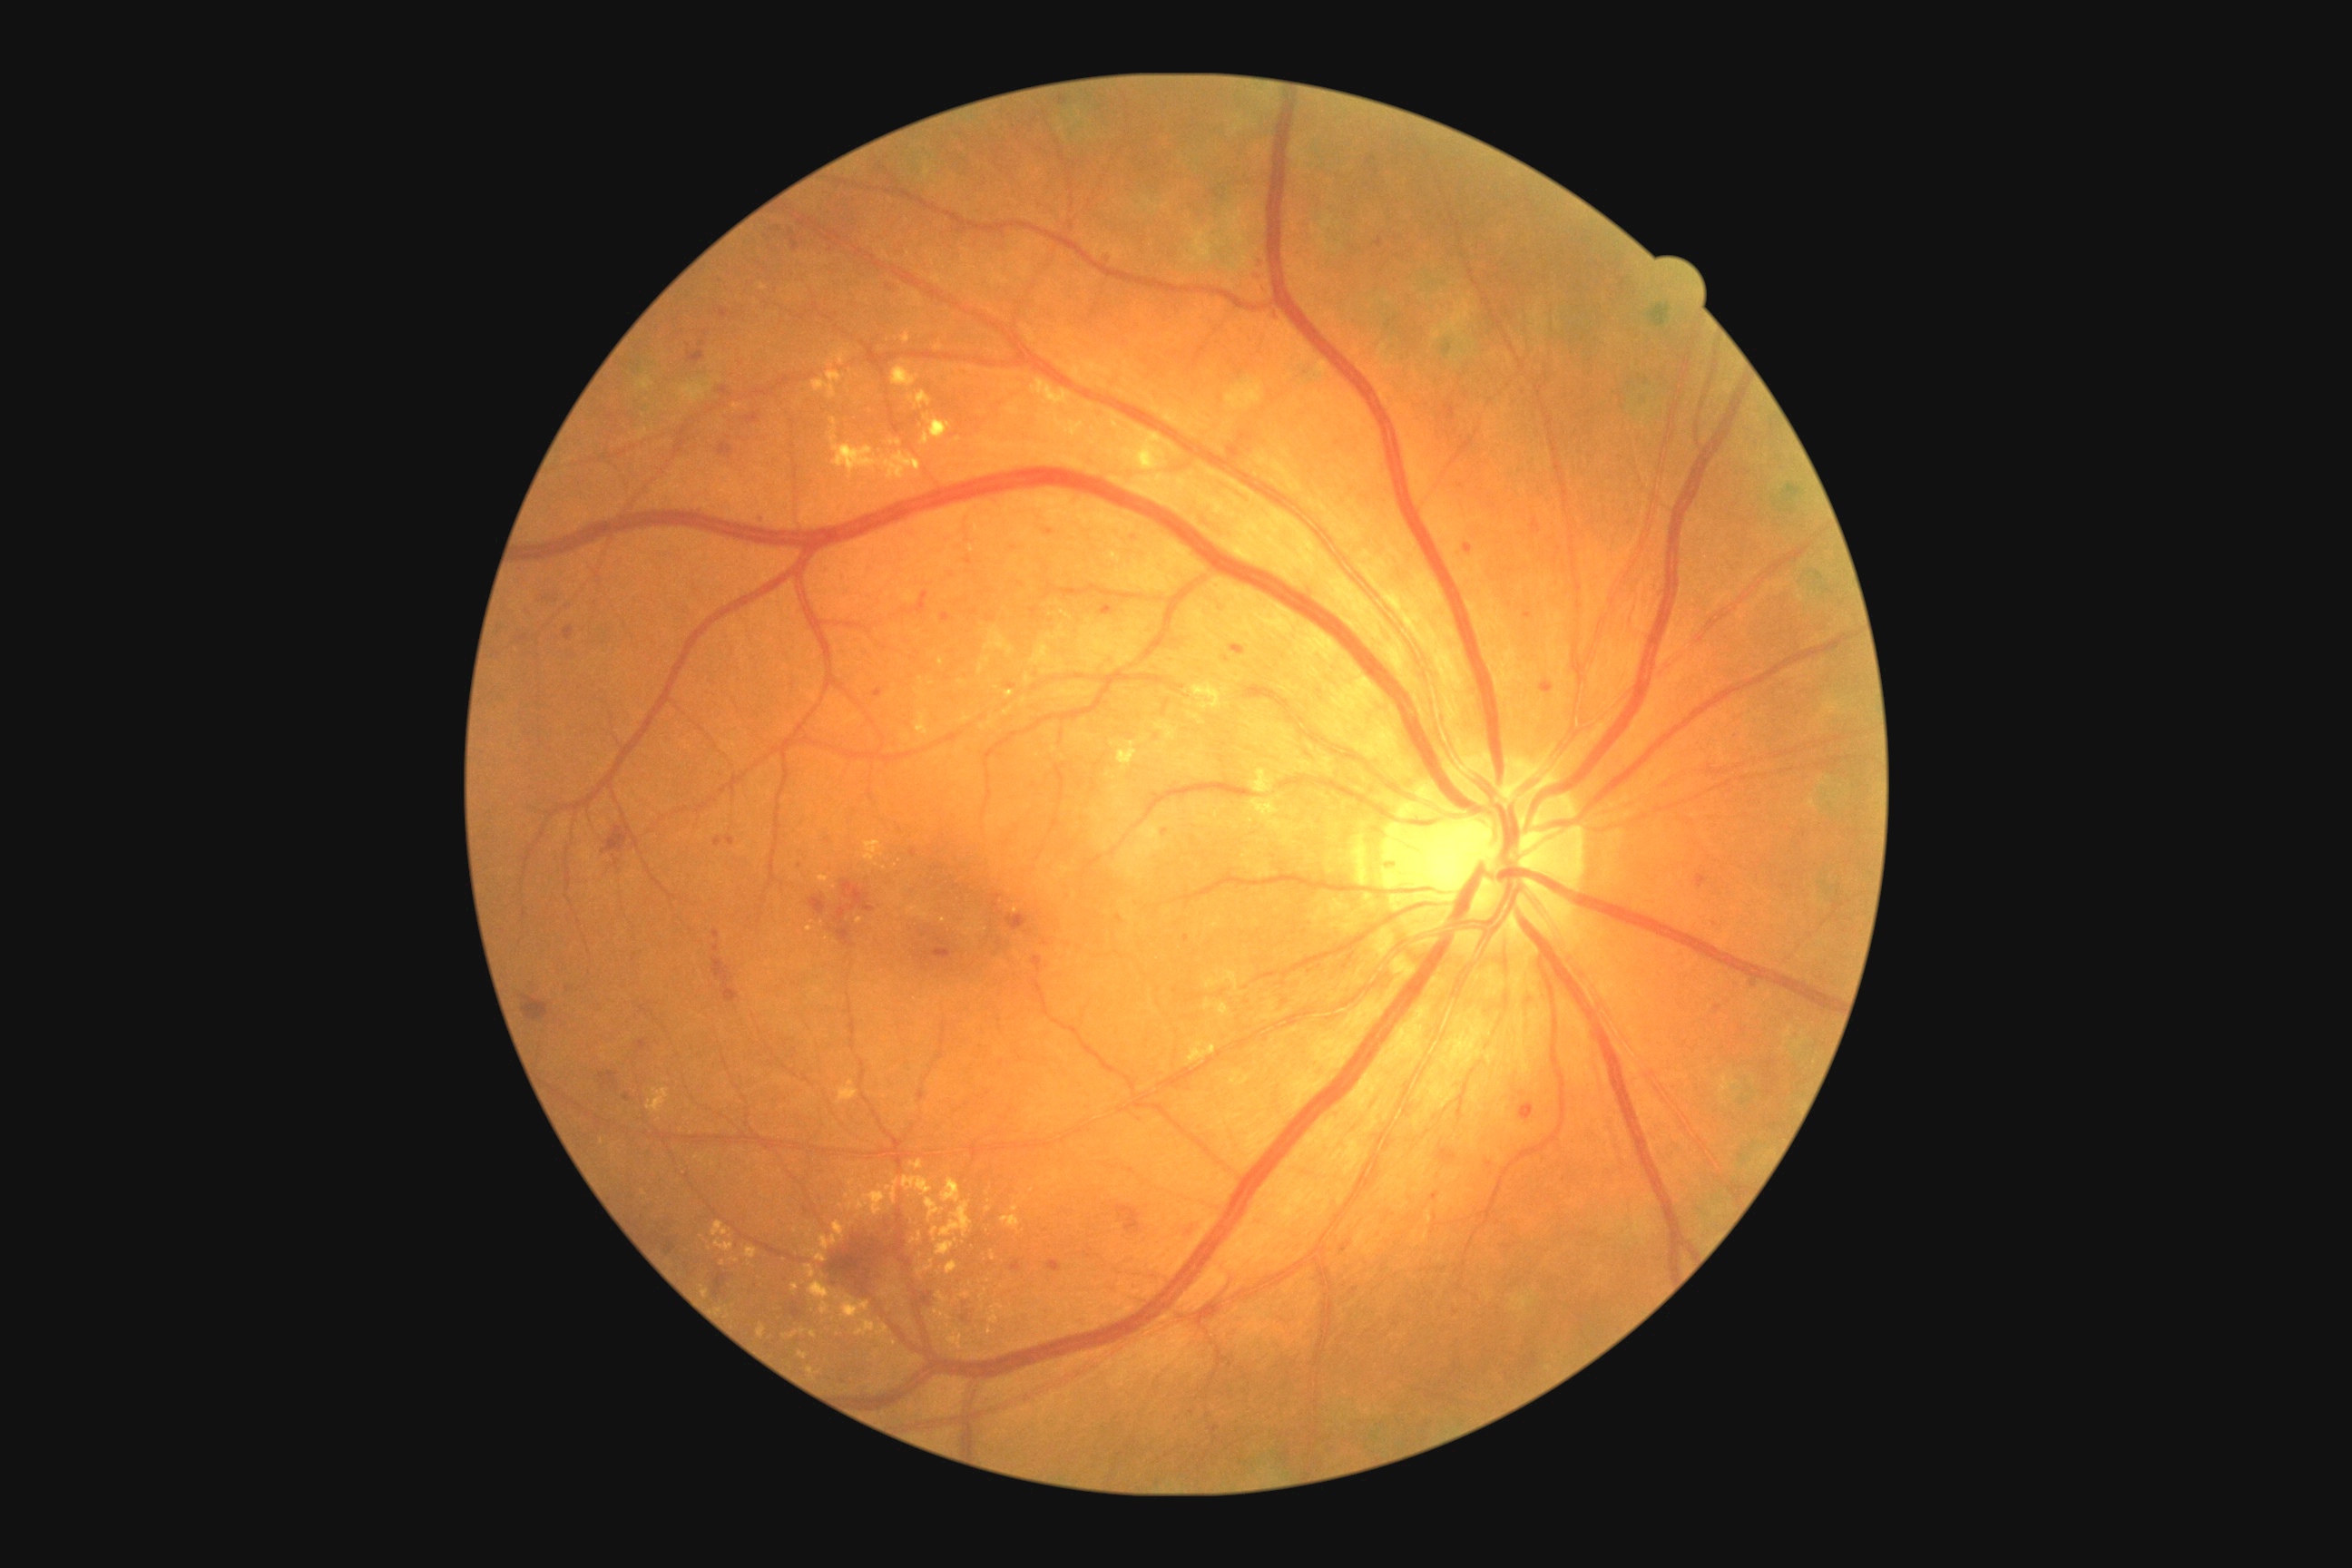
{"partial": true, "dr_grade": 2, "dr_grade_name": "moderate NPDR", "lesions": {"ex": [[943, 1179, 961, 1204], [1427, 1210, 1433, 1224], [858, 917, 865, 925], [712, 1220, 729, 1237], [856, 1318, 888, 1337], [937, 1239, 959, 1255], [714, 1240, 734, 1251], [830, 418, 838, 435], [812, 371, 845, 400], [701, 1286, 709, 1298], [819, 1220, 845, 1250], [805, 1266, 816, 1279]], "ex_small_approx": [[989, 1210], [907, 737], [910, 1324], [796, 1231], [1026, 1199], [810, 1234], [809, 929]]}}